268x268px, optic disc region of a color fundus photo, 35° FOV before cropping — 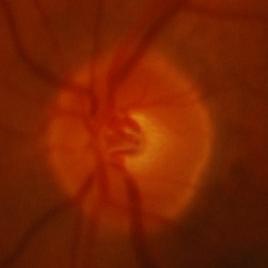
The image shows glaucomatous findings.